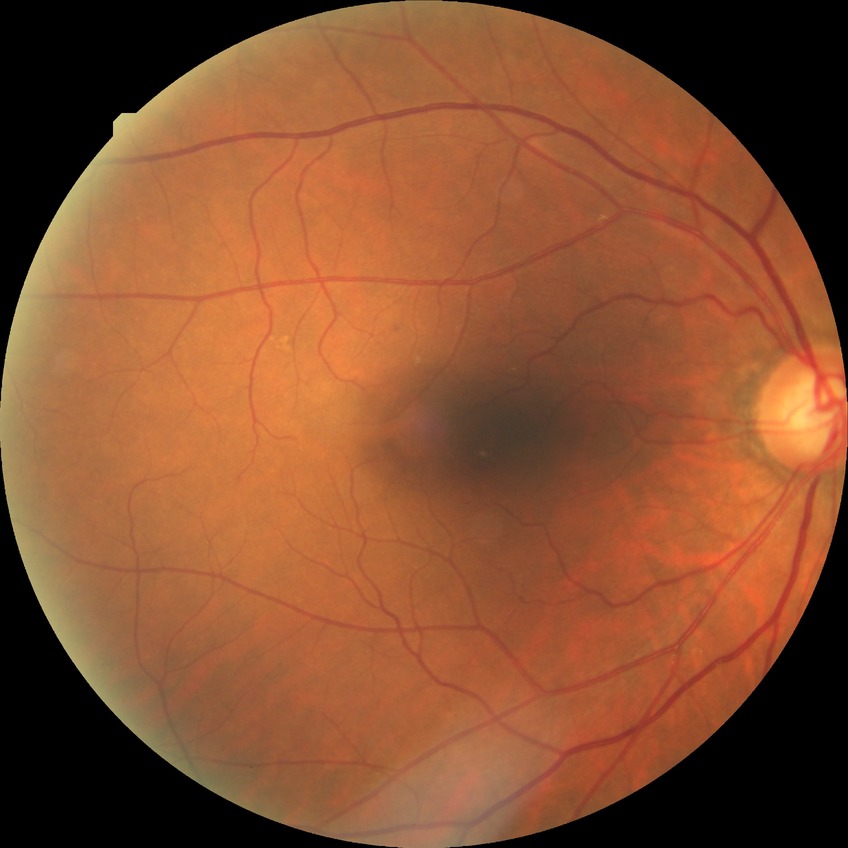

Diabetic retinopathy (DR): no diabetic retinopathy (NDR).